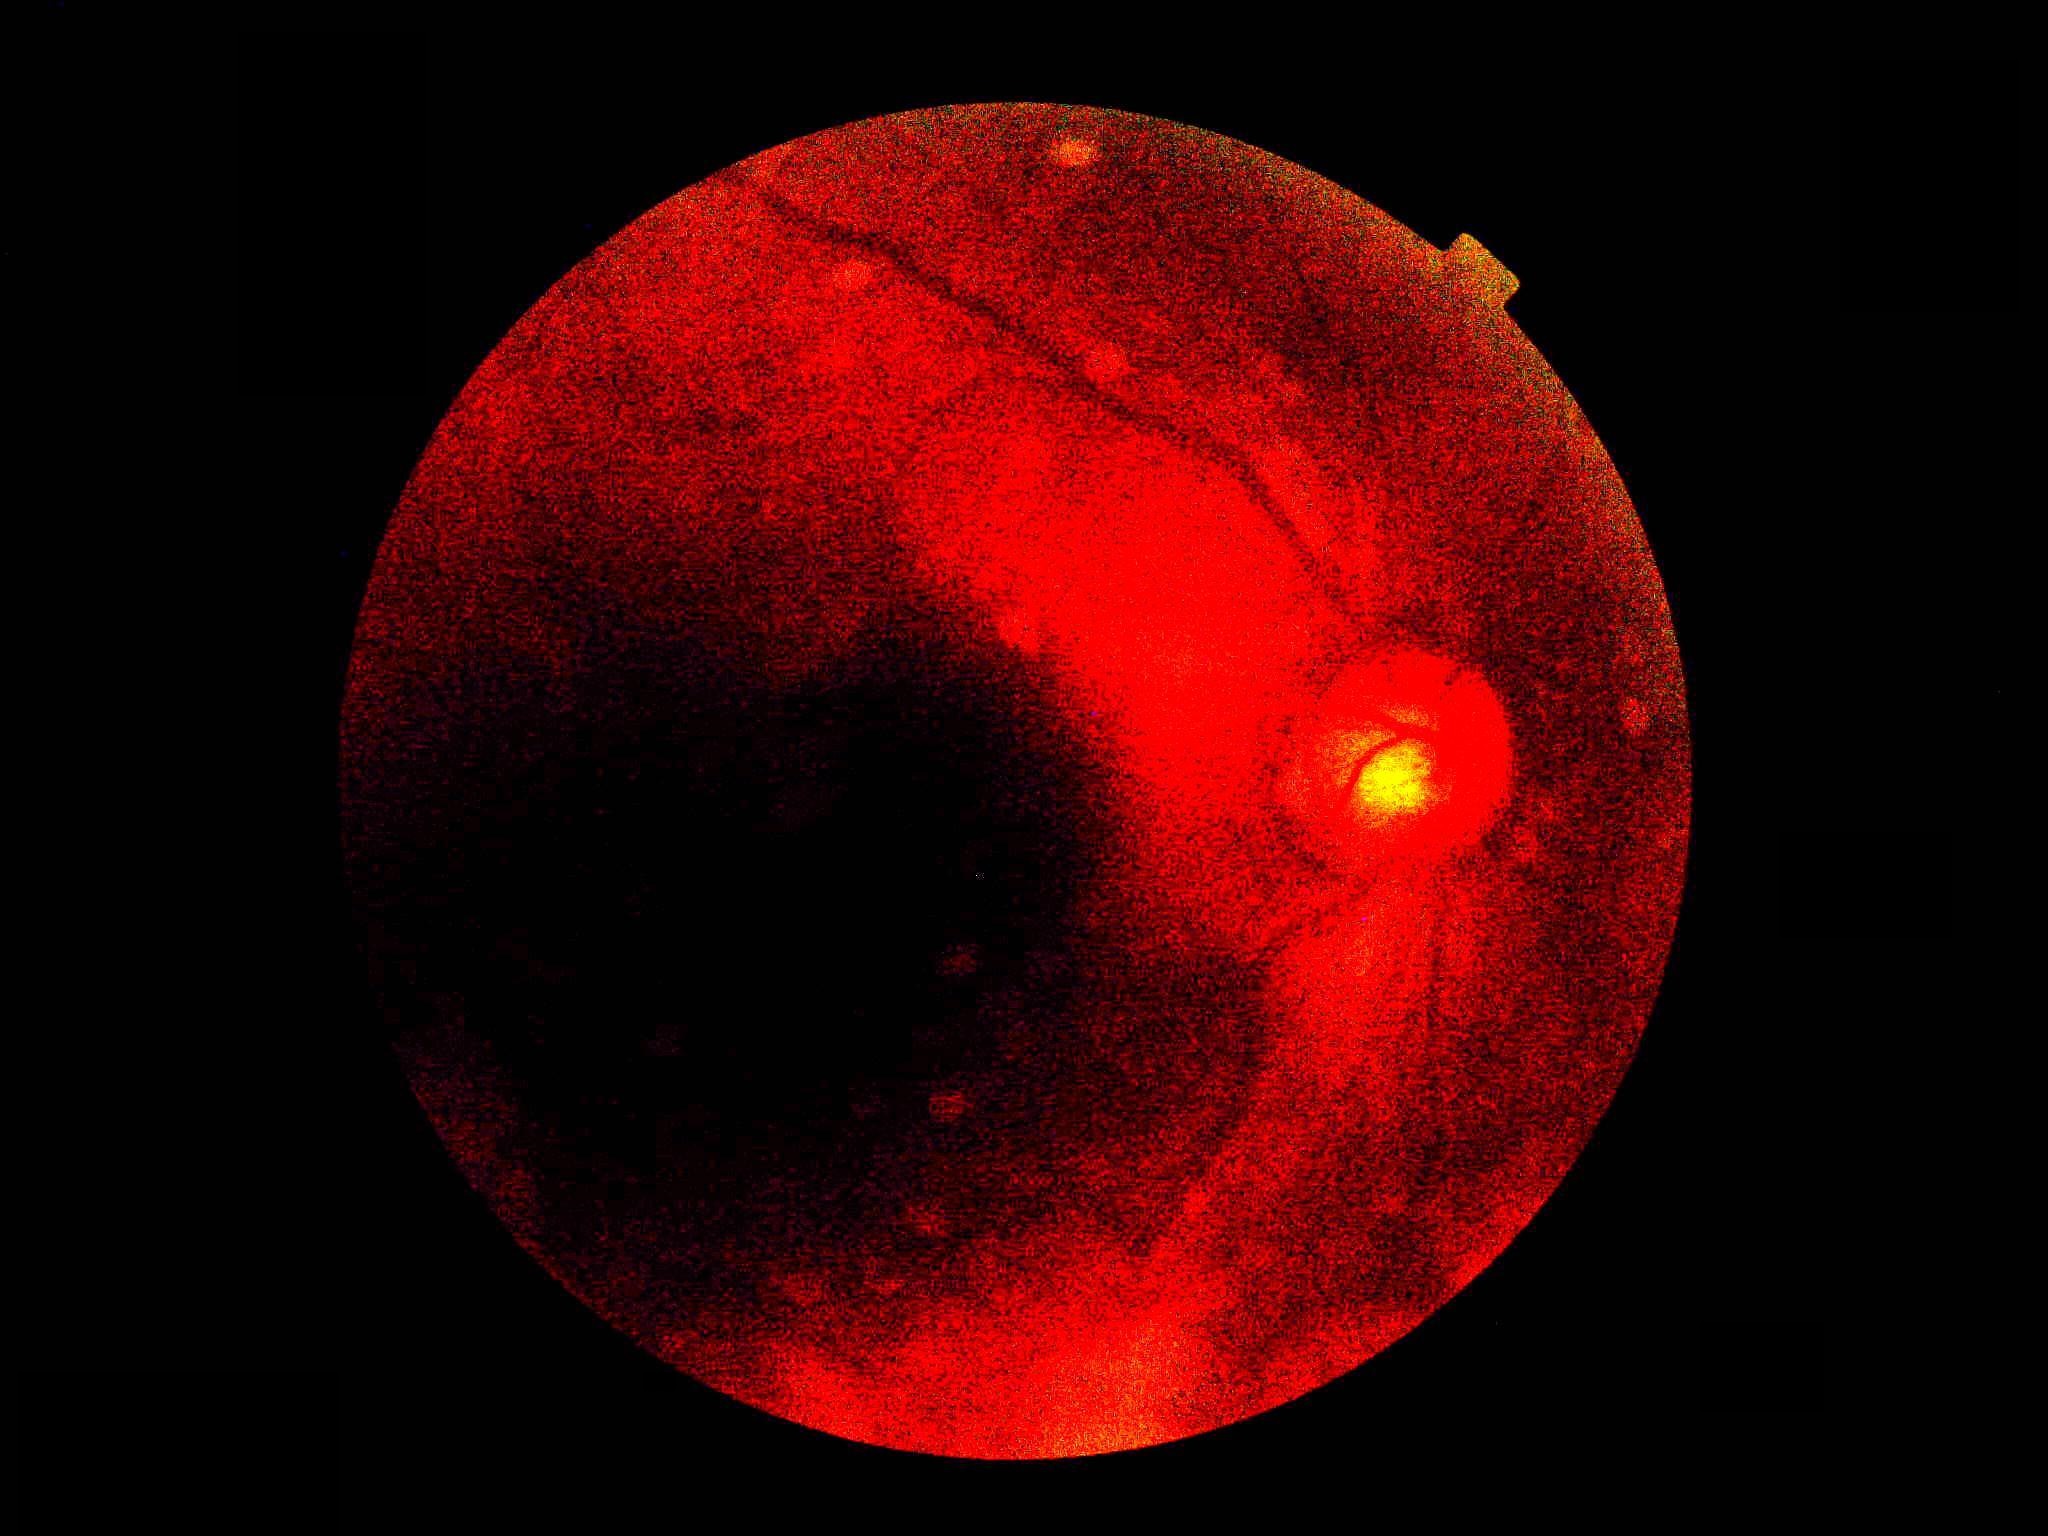
dr_grade: ungradable
quality: below grading threshold